Color fundus photograph centered on the optic disc: 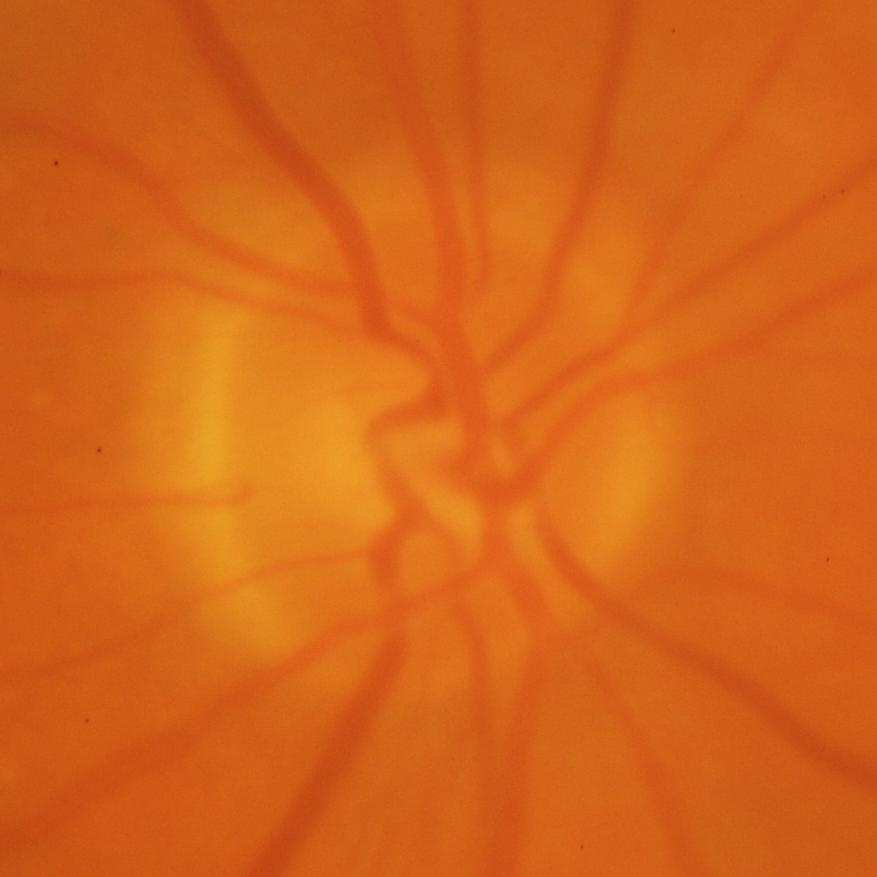 Showing glaucomatous changes.